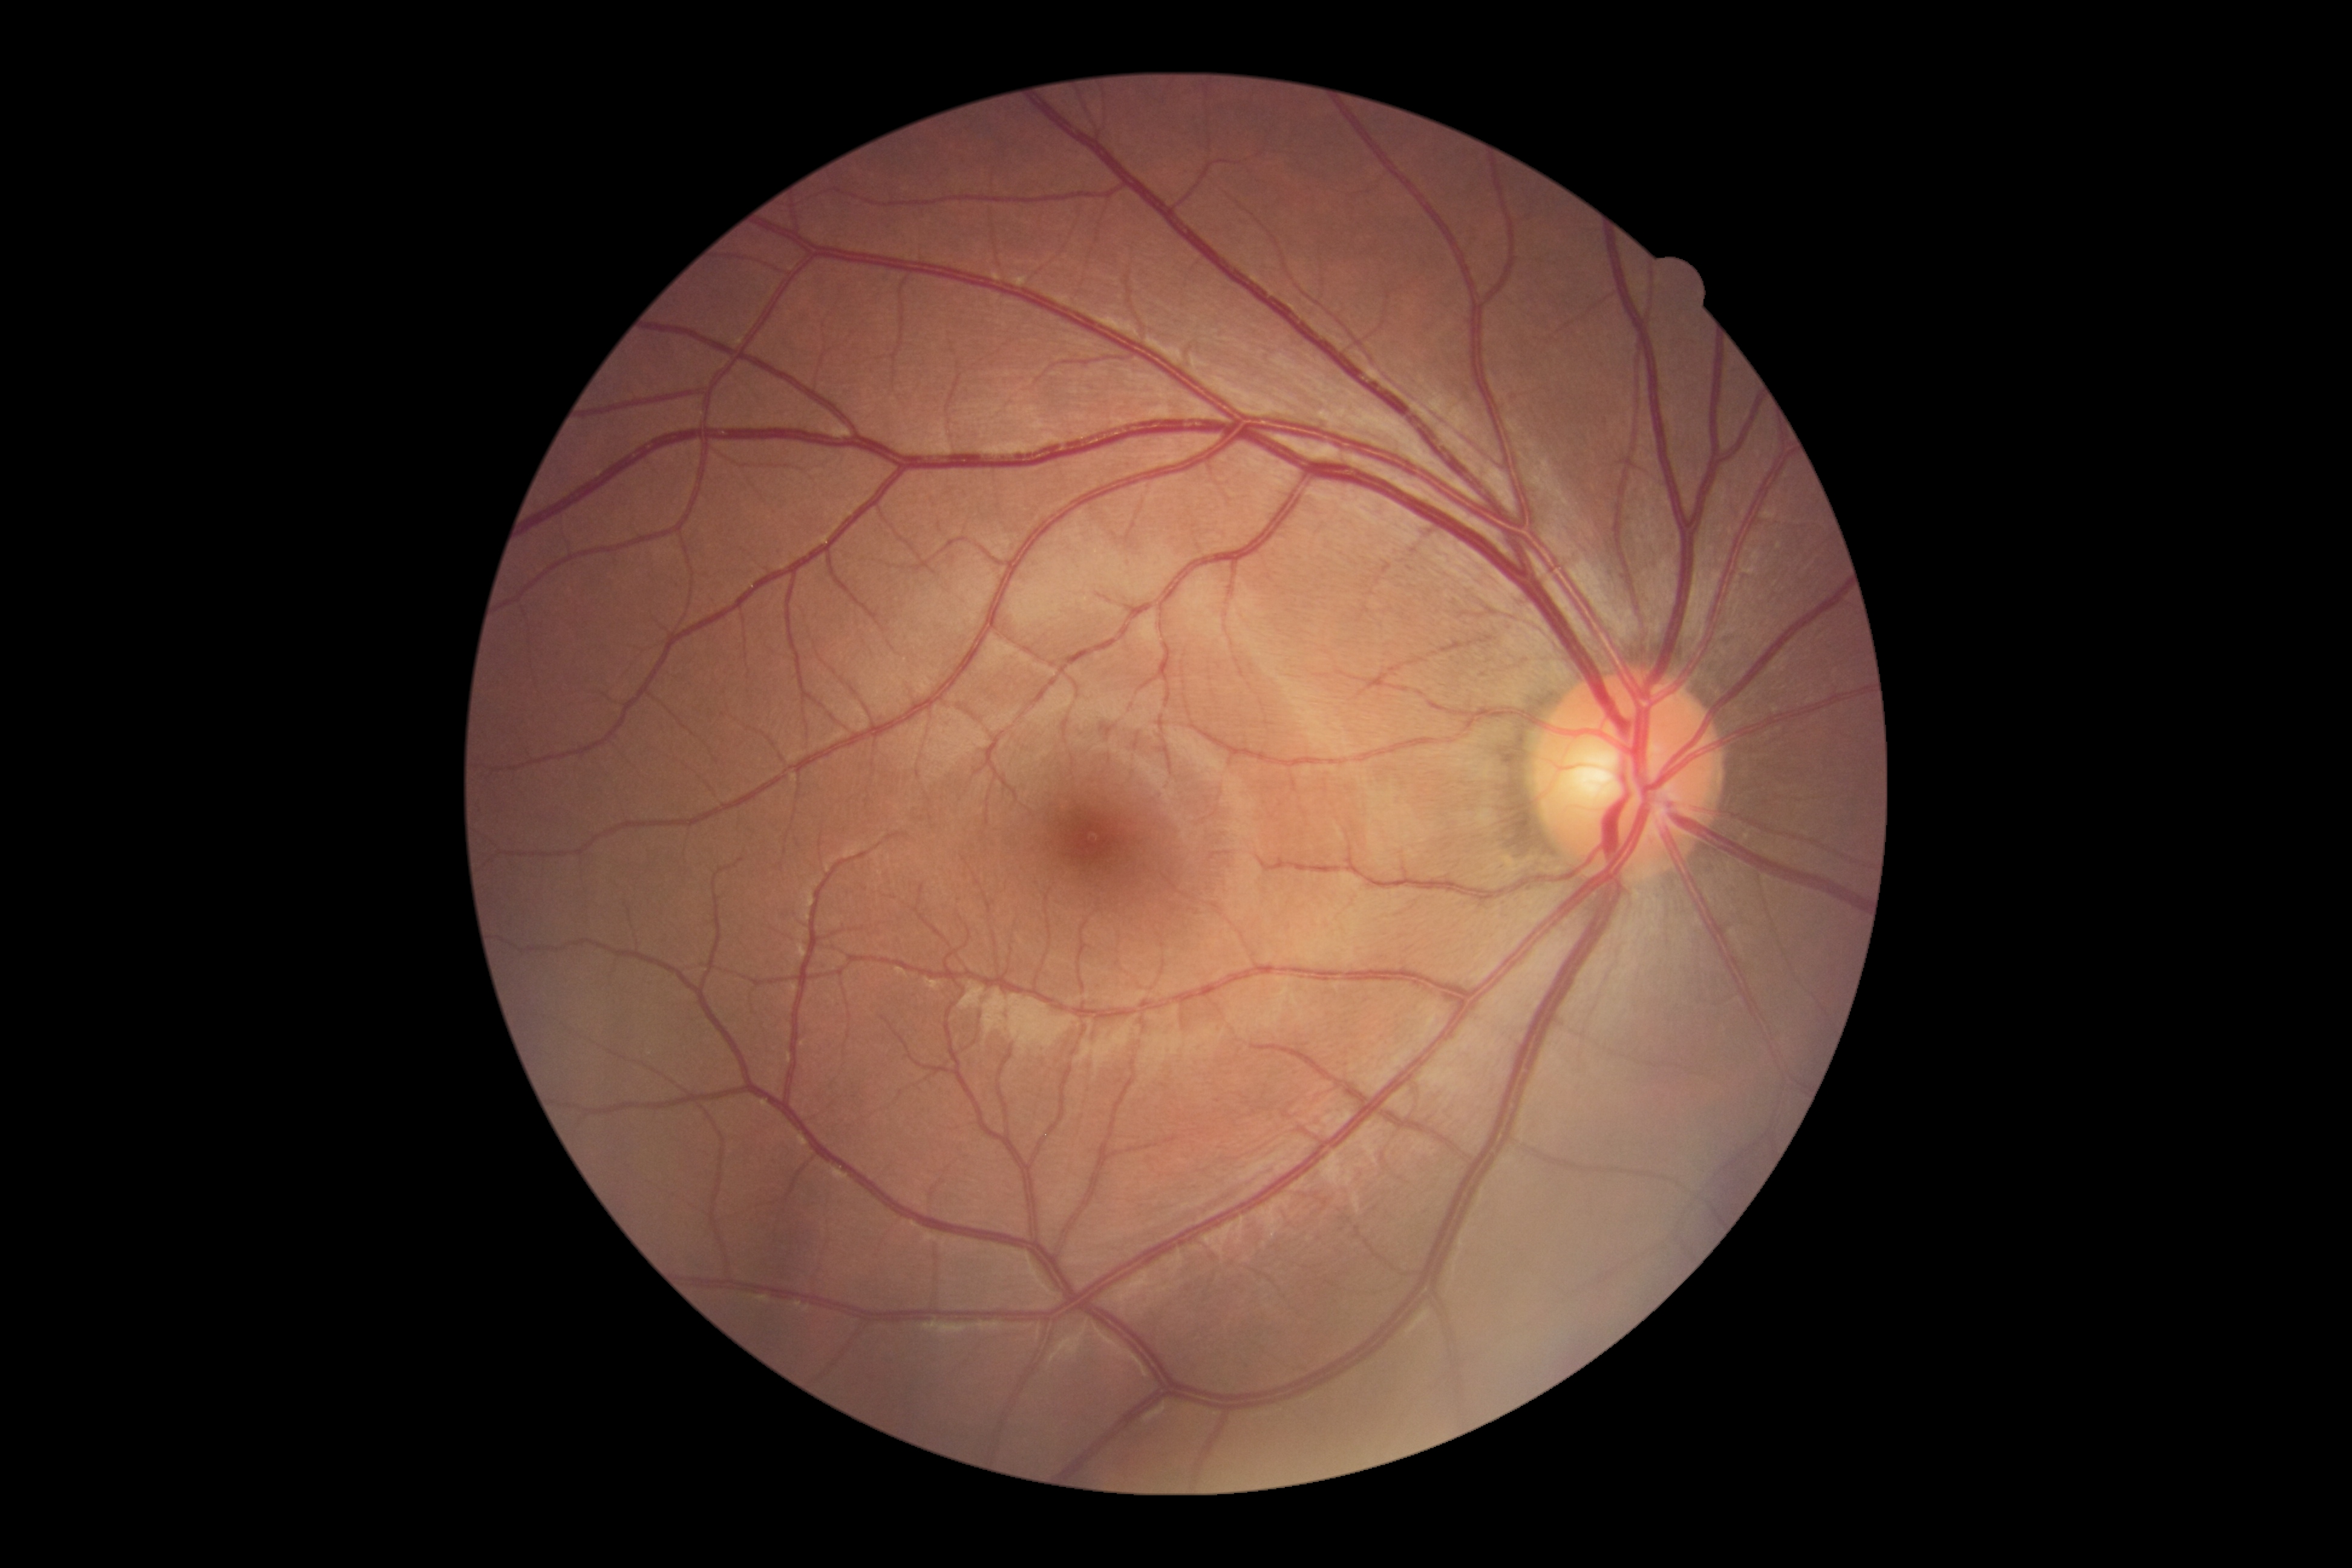 DR stage = 0/4 — no visible signs of diabetic retinopathy
DR impression = no signs of DR